45-degree field of view:
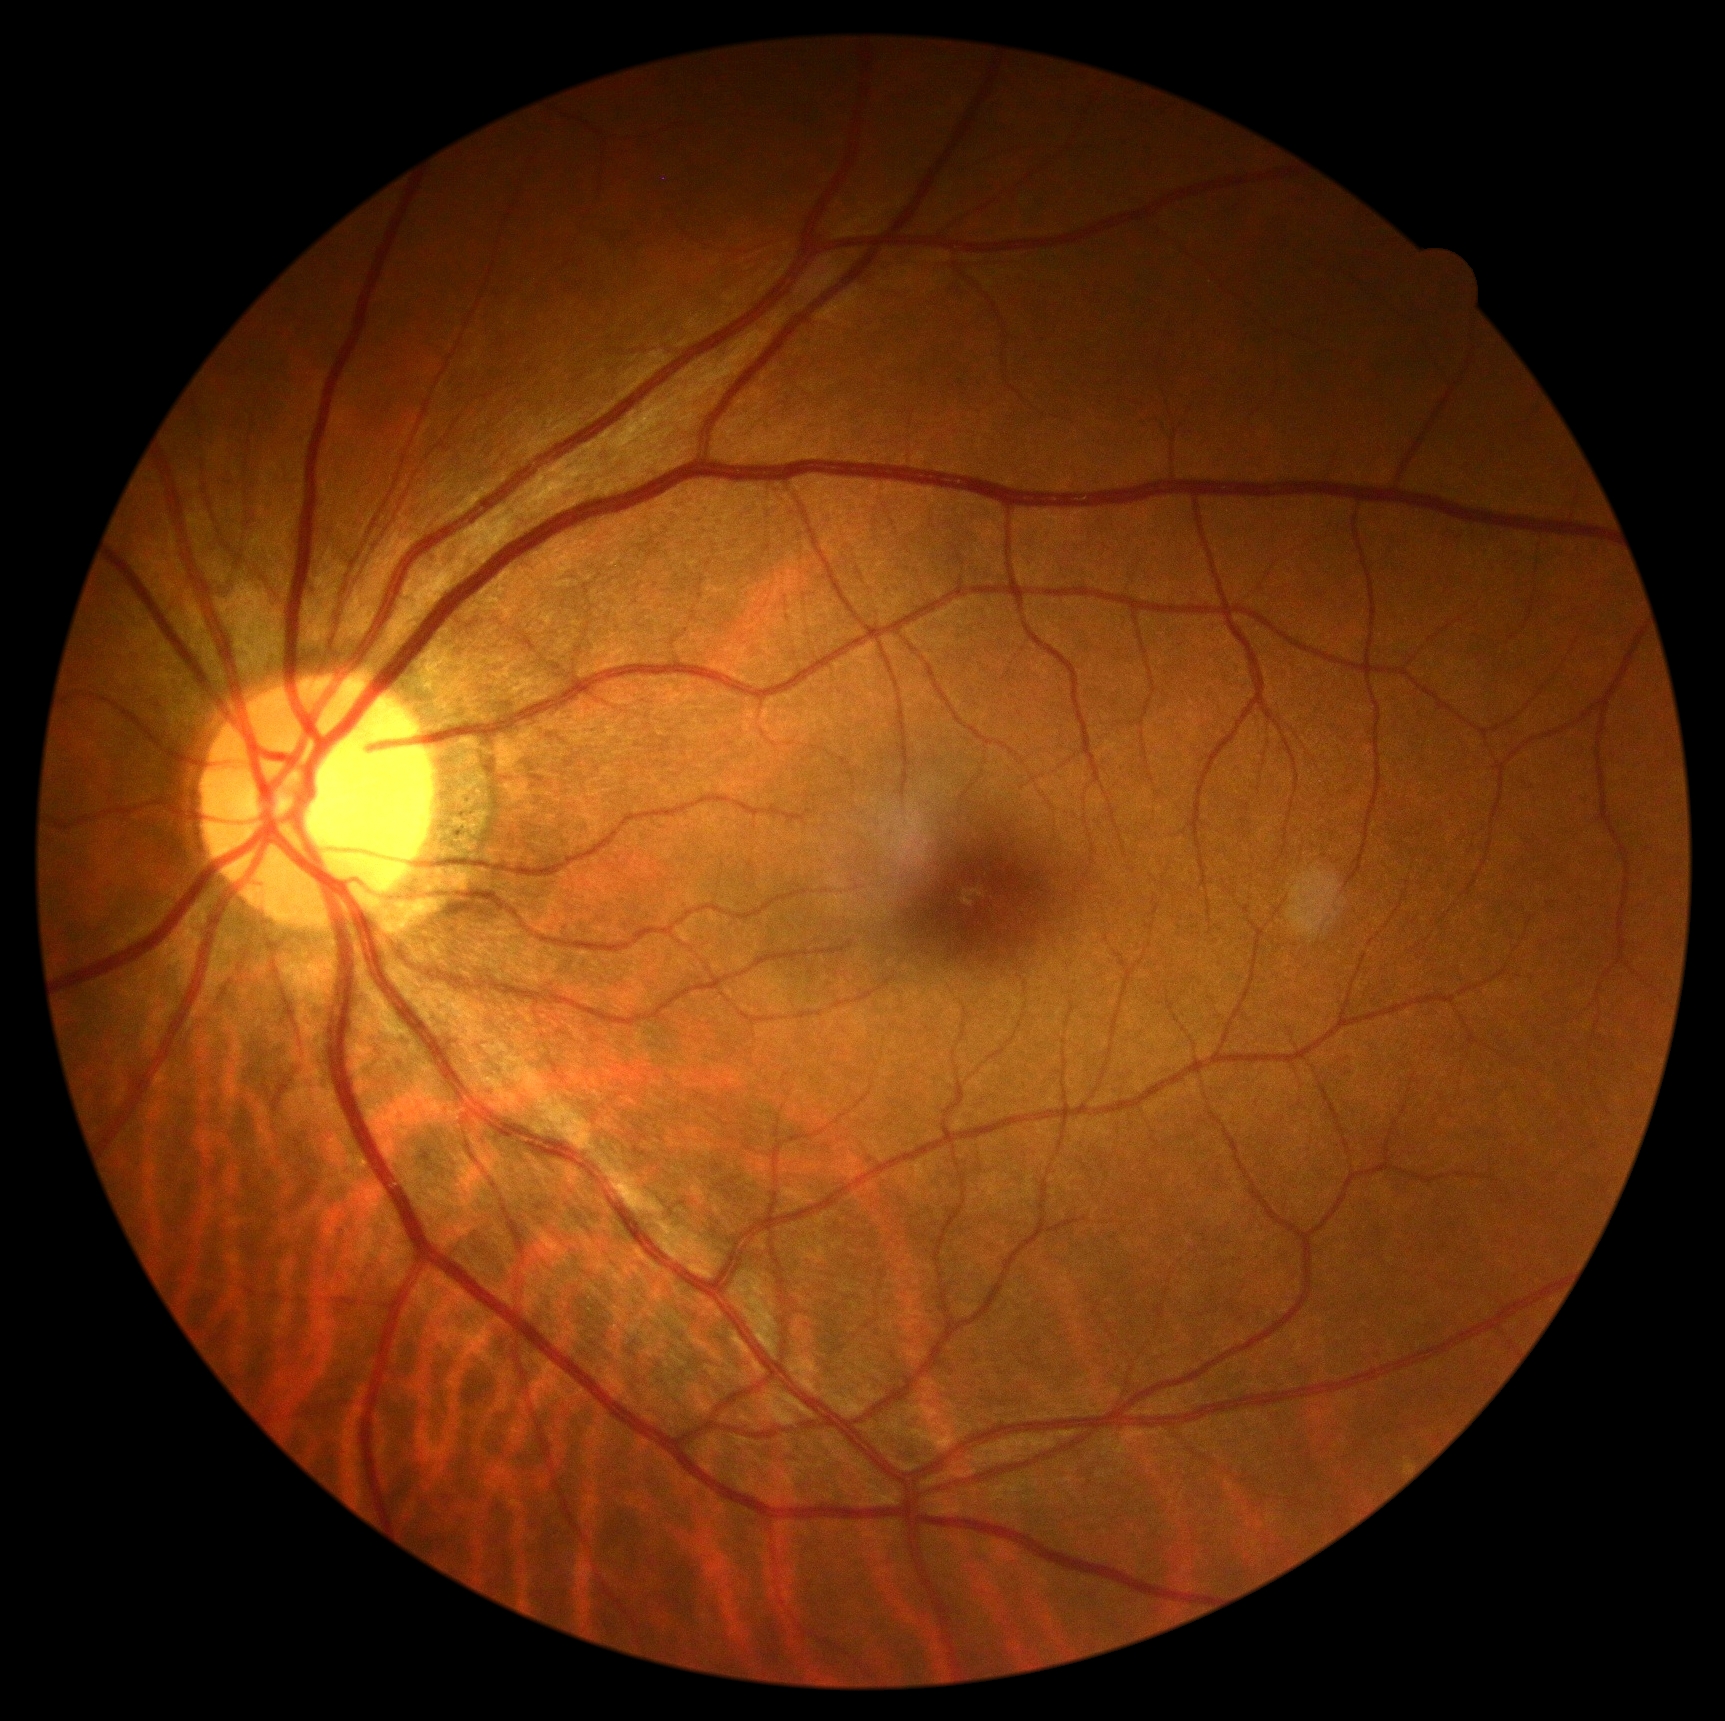

DR impression@no DR findings, diabetic retinopathy grade@0 (no apparent retinopathy).